Modified Davis grading · 45° field of view · no pharmacologic dilation
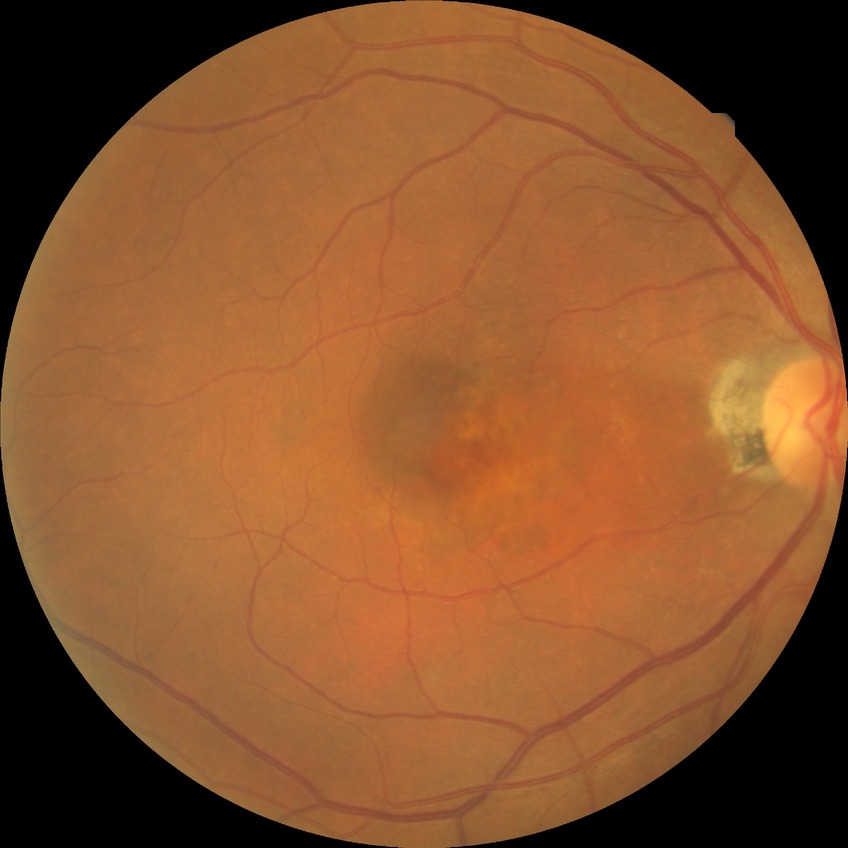

diabetic retinopathy (DR) = no diabetic retinopathy (NDR).